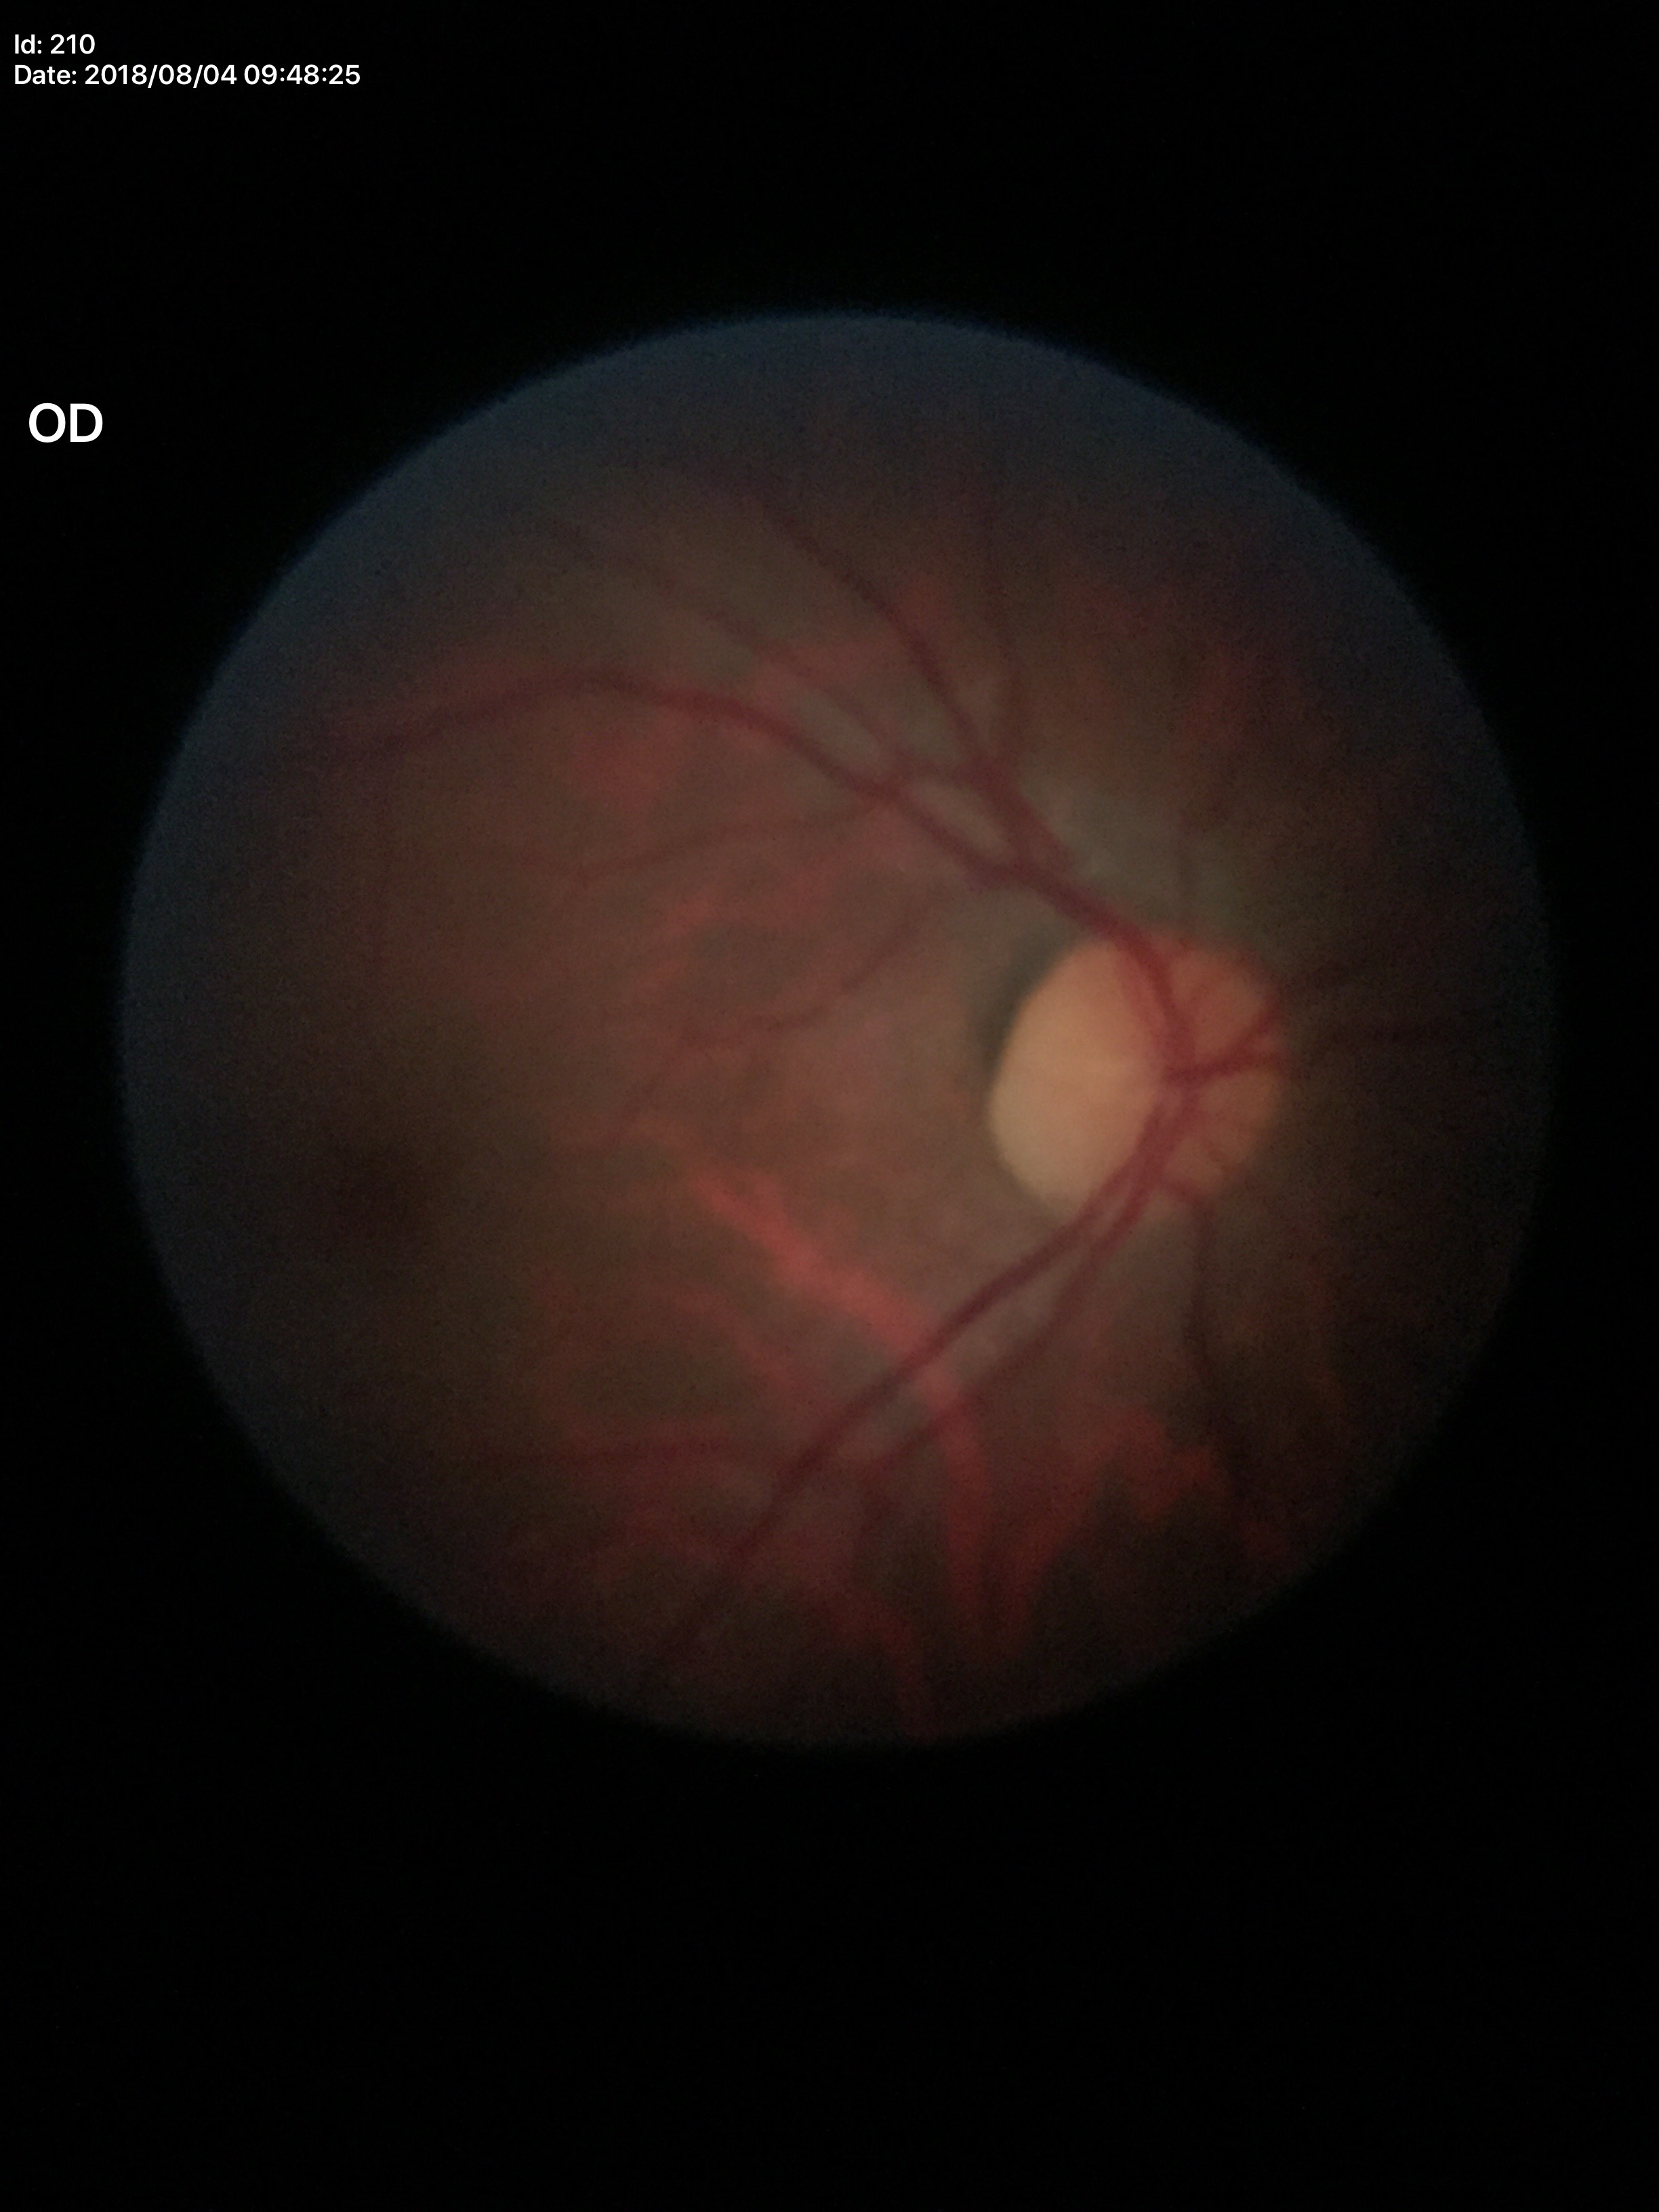

* Glaucoma screening: no suspicious findings
* vertical CDR (VCDR): 0.44